Image size 1932x1910: 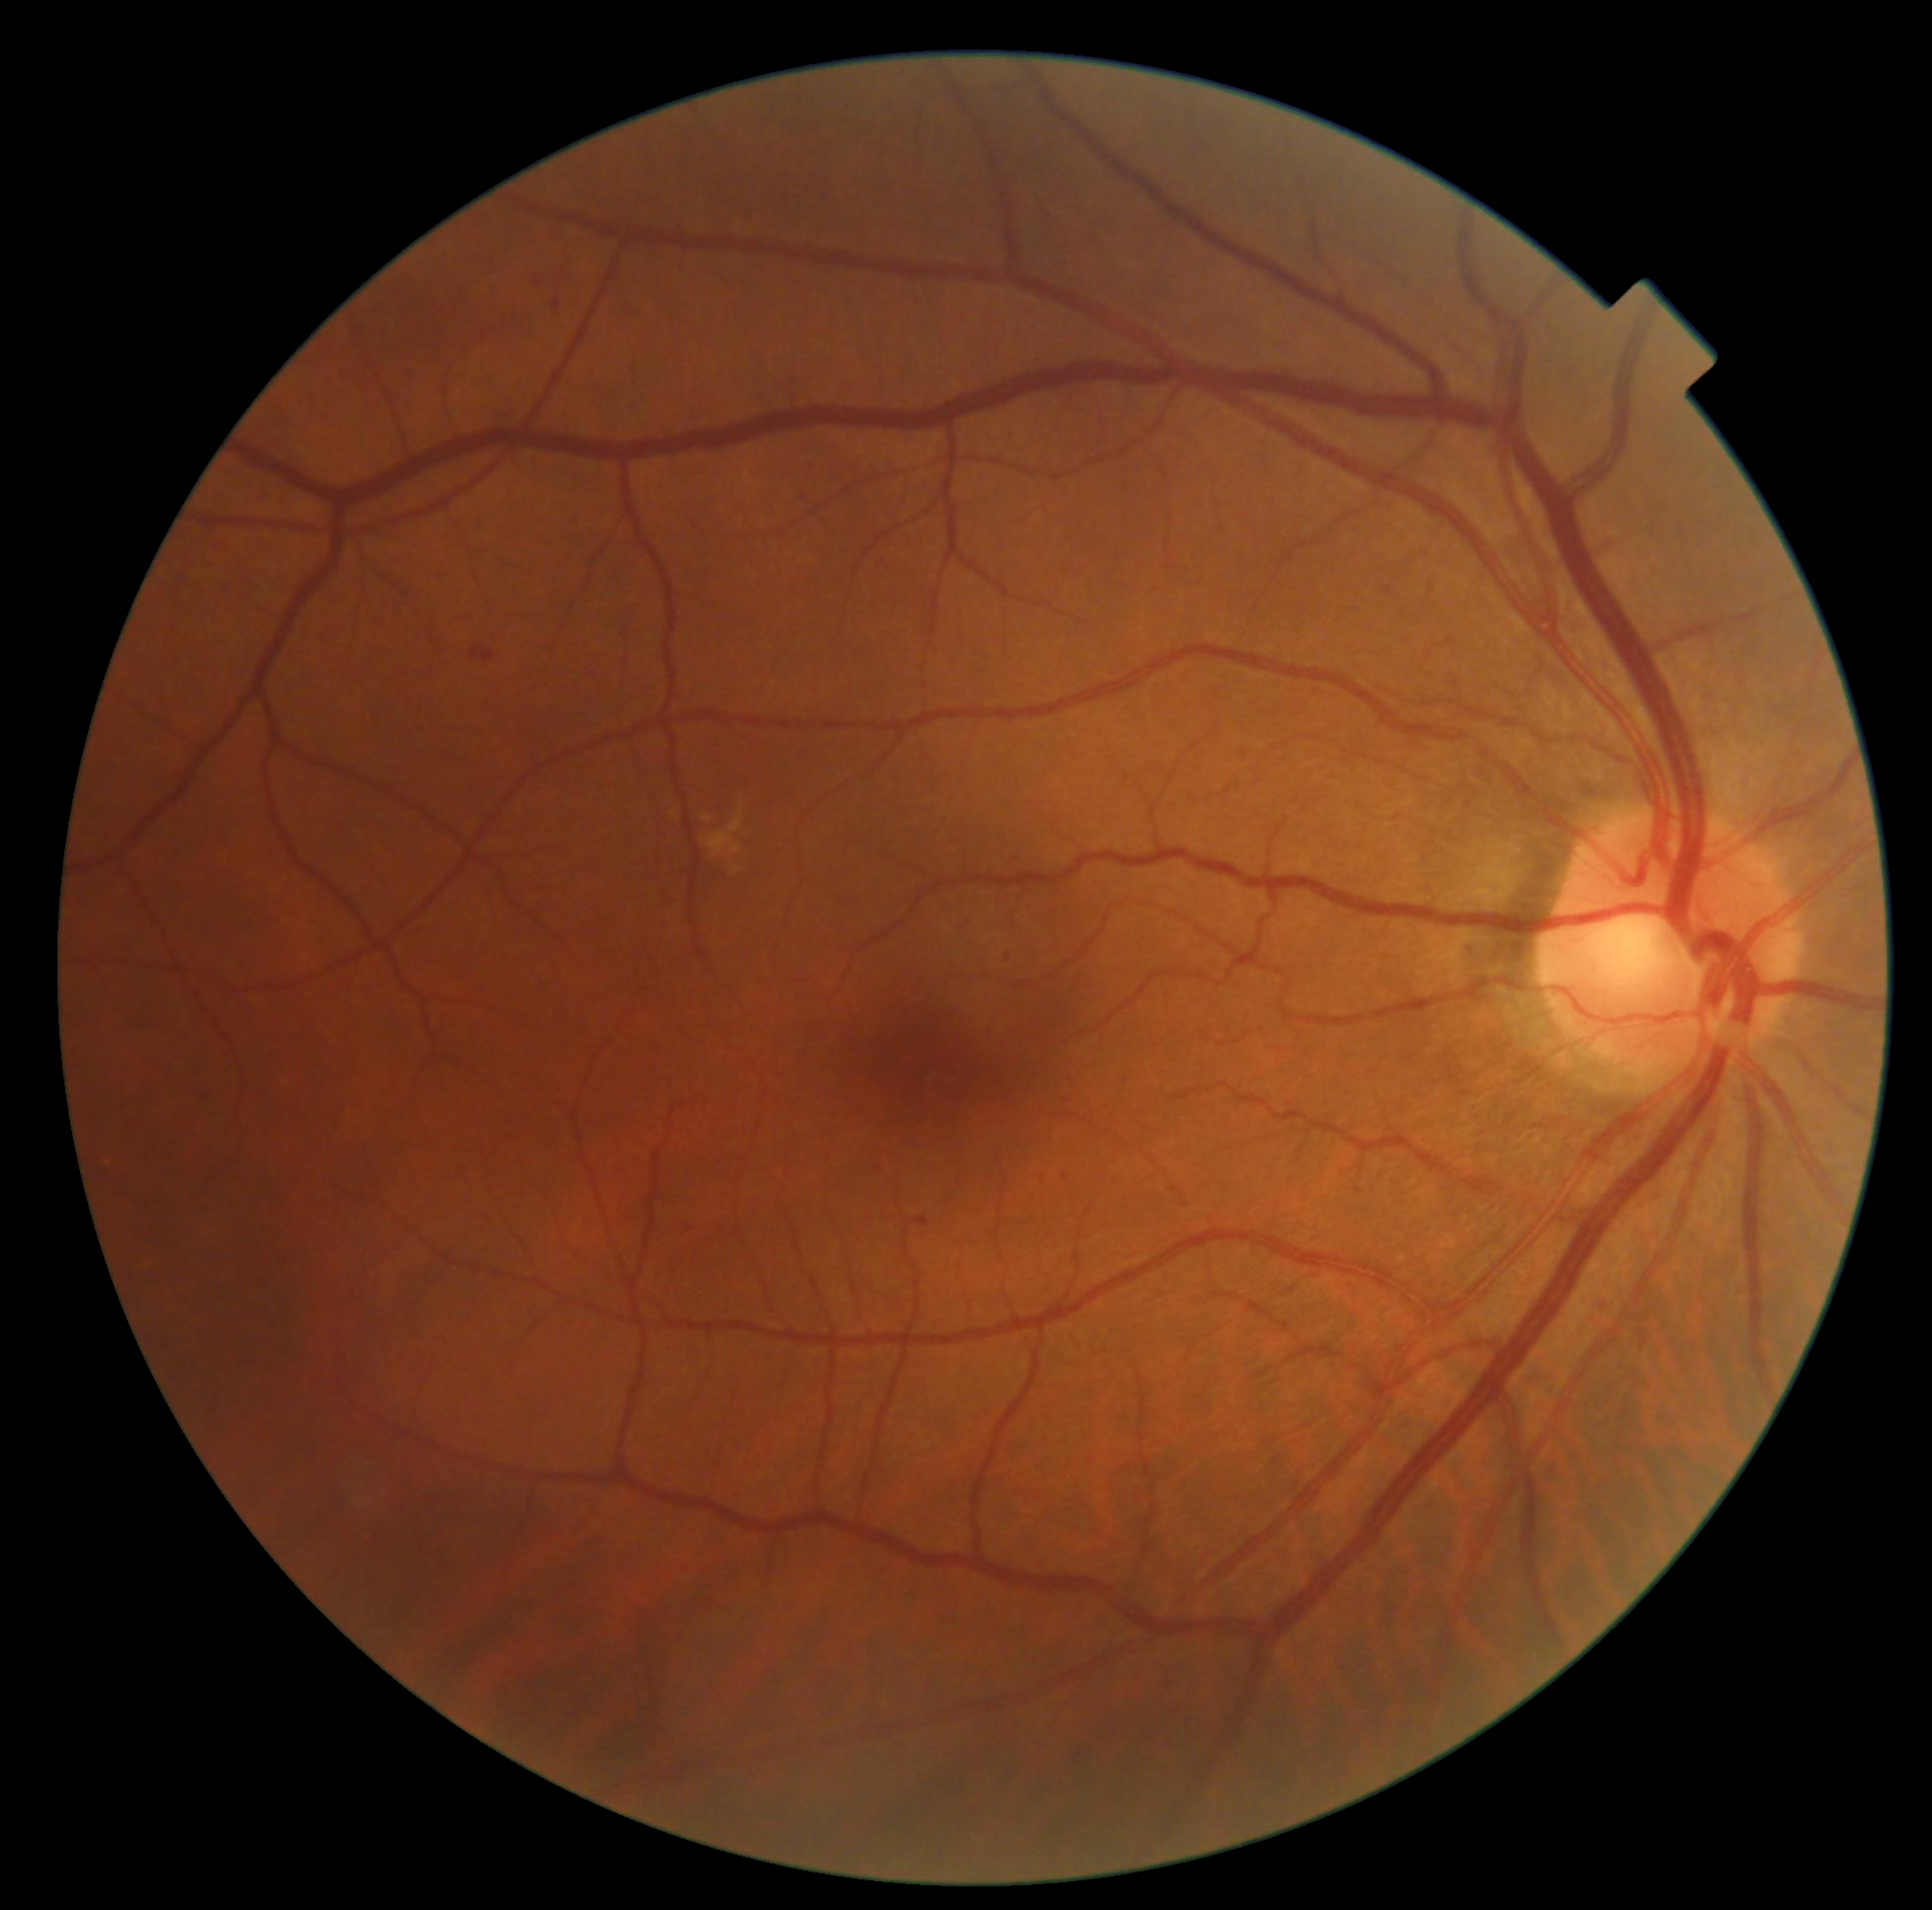

Retinopathy: grade 2.